FOV: 45 degrees; modified Davis grading — 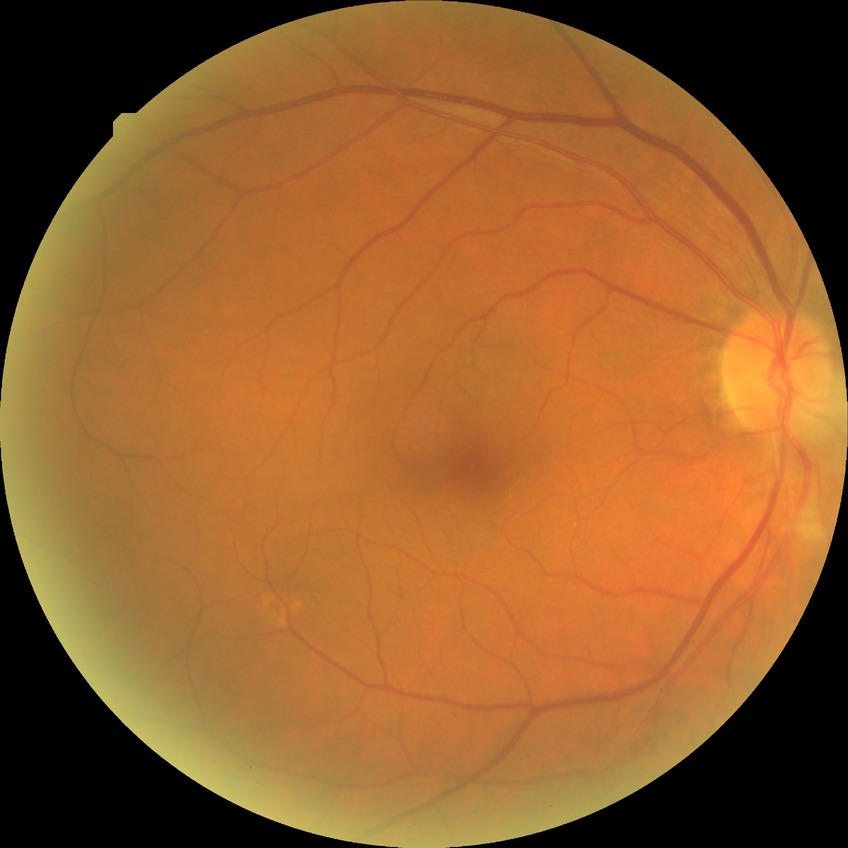 Diabetic retinopathy (DR): simple diabetic retinopathy (SDR).